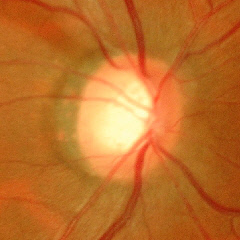 There is evidence of advanced-stage glaucoma.